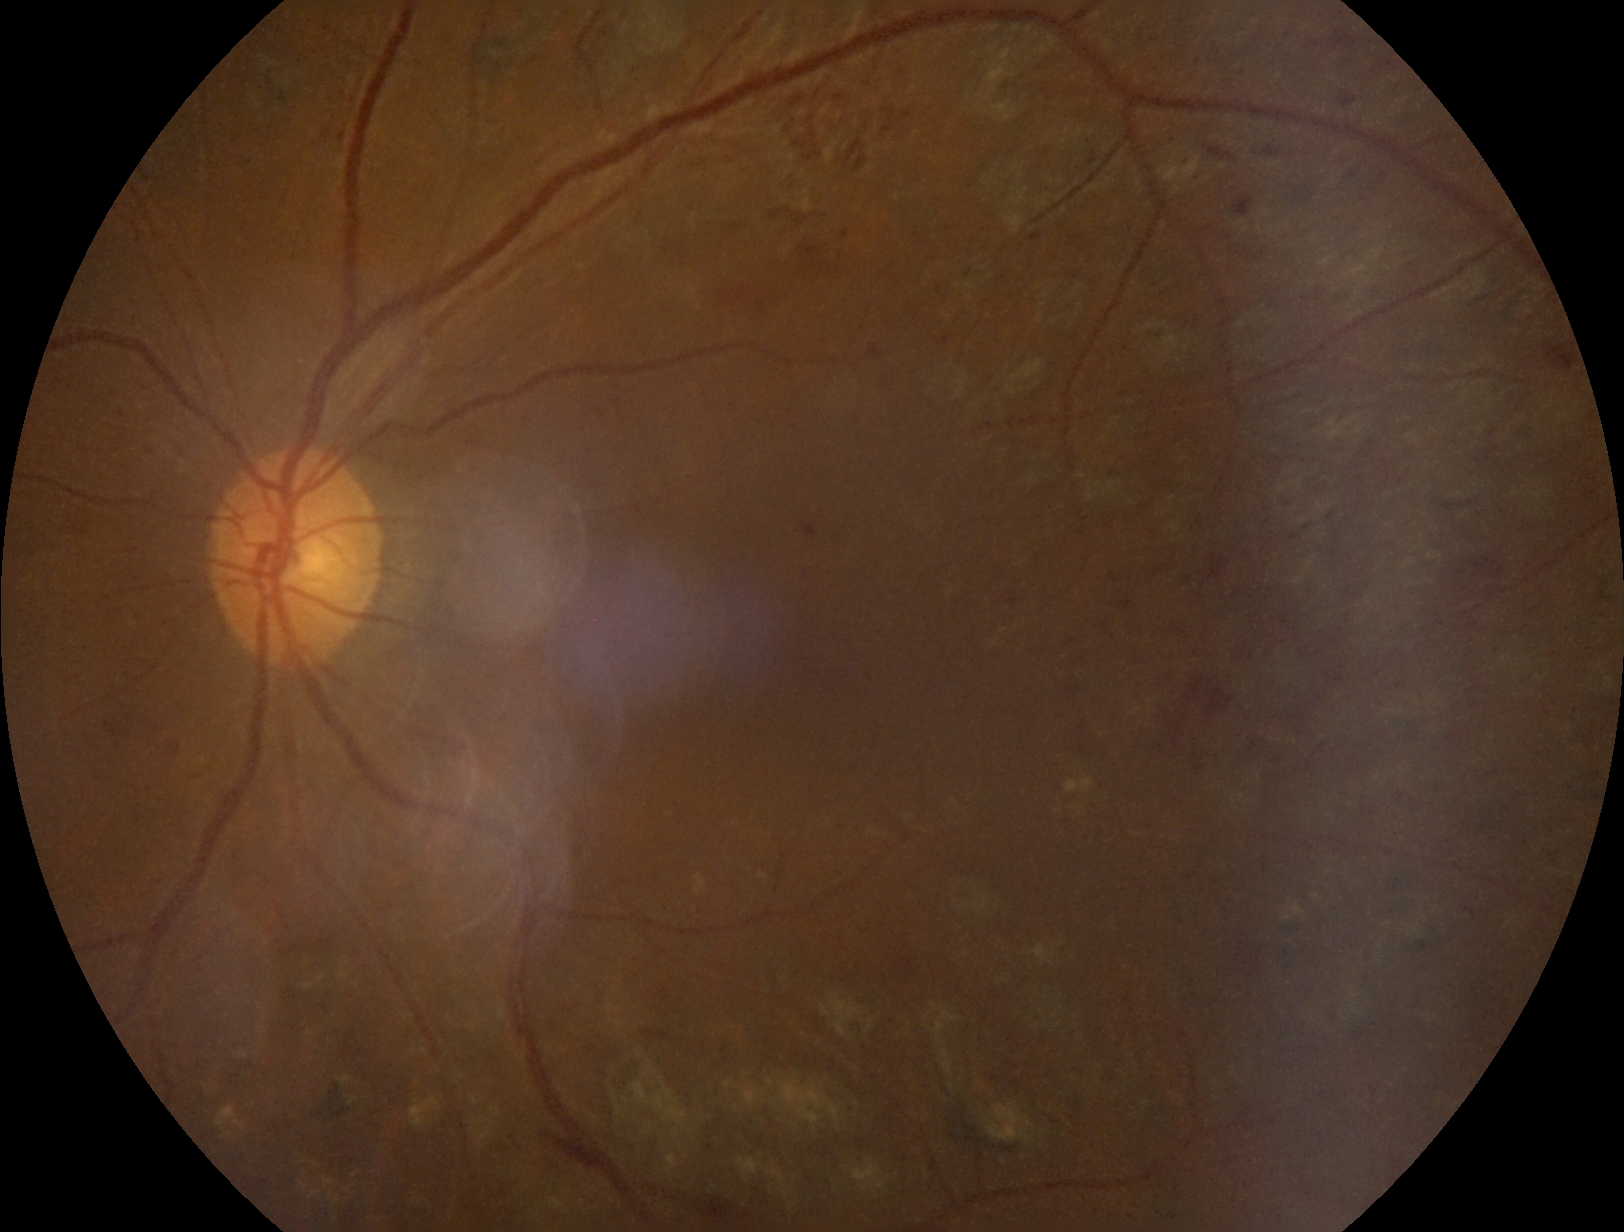 Diabetic retinopathy severity: grade 2 (moderate NPDR) — more than just microaneurysms but less than severe NPDR.